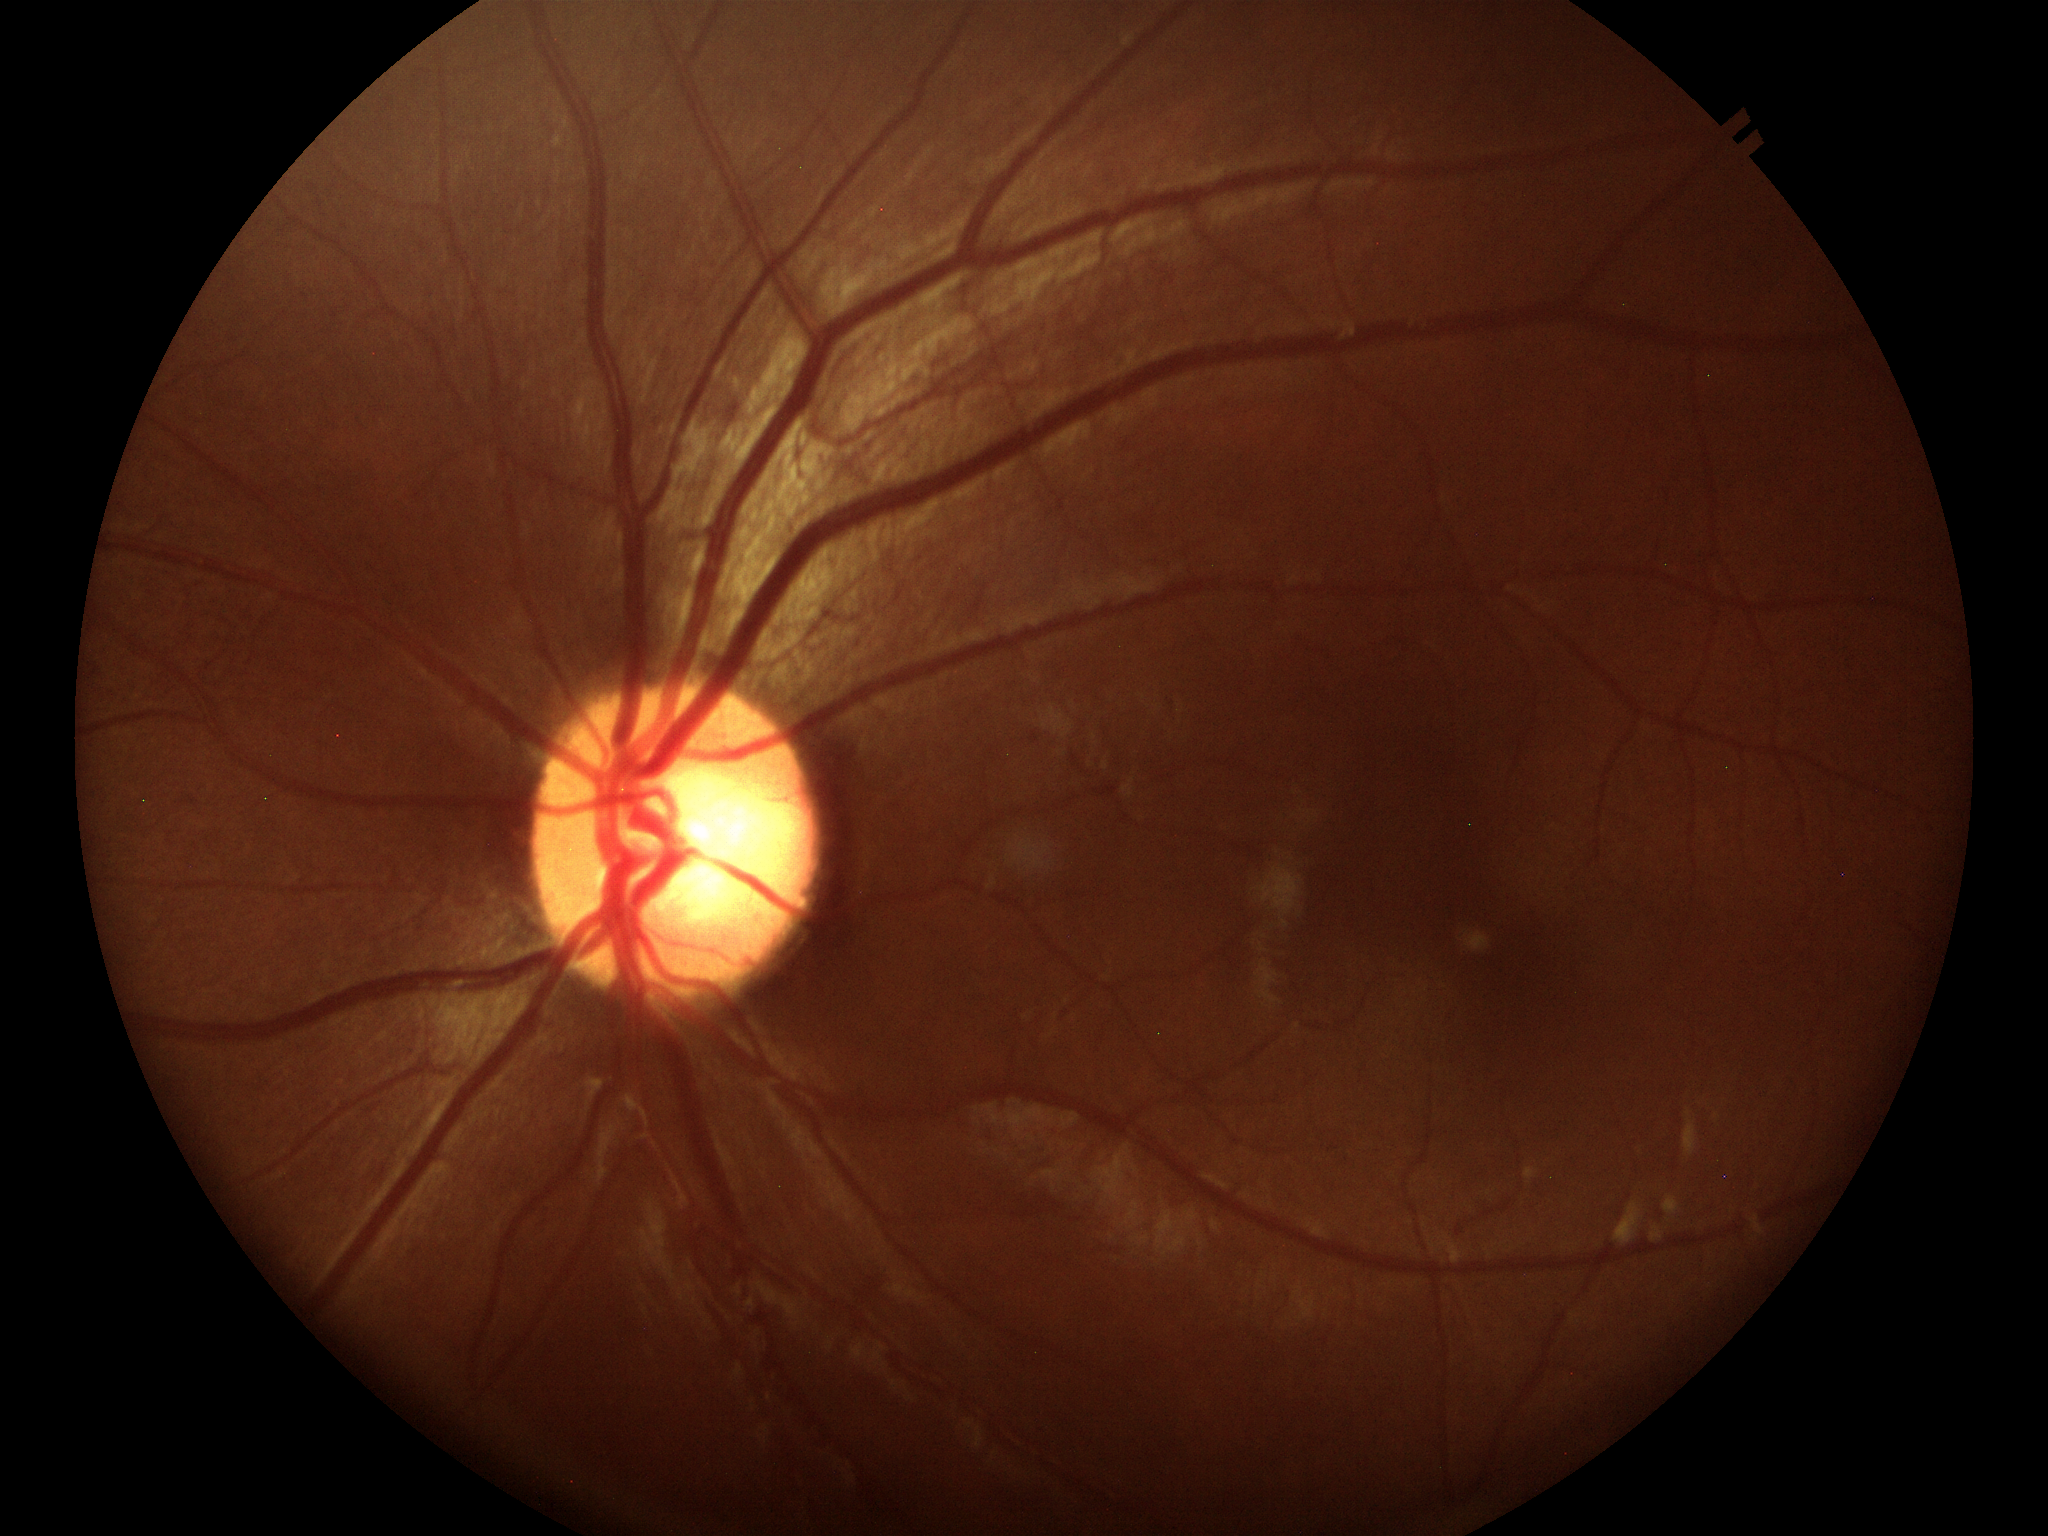

Glaucoma assessment=not suspect (5/5 ophthalmologists in agreement) | vertical CDR=0.56